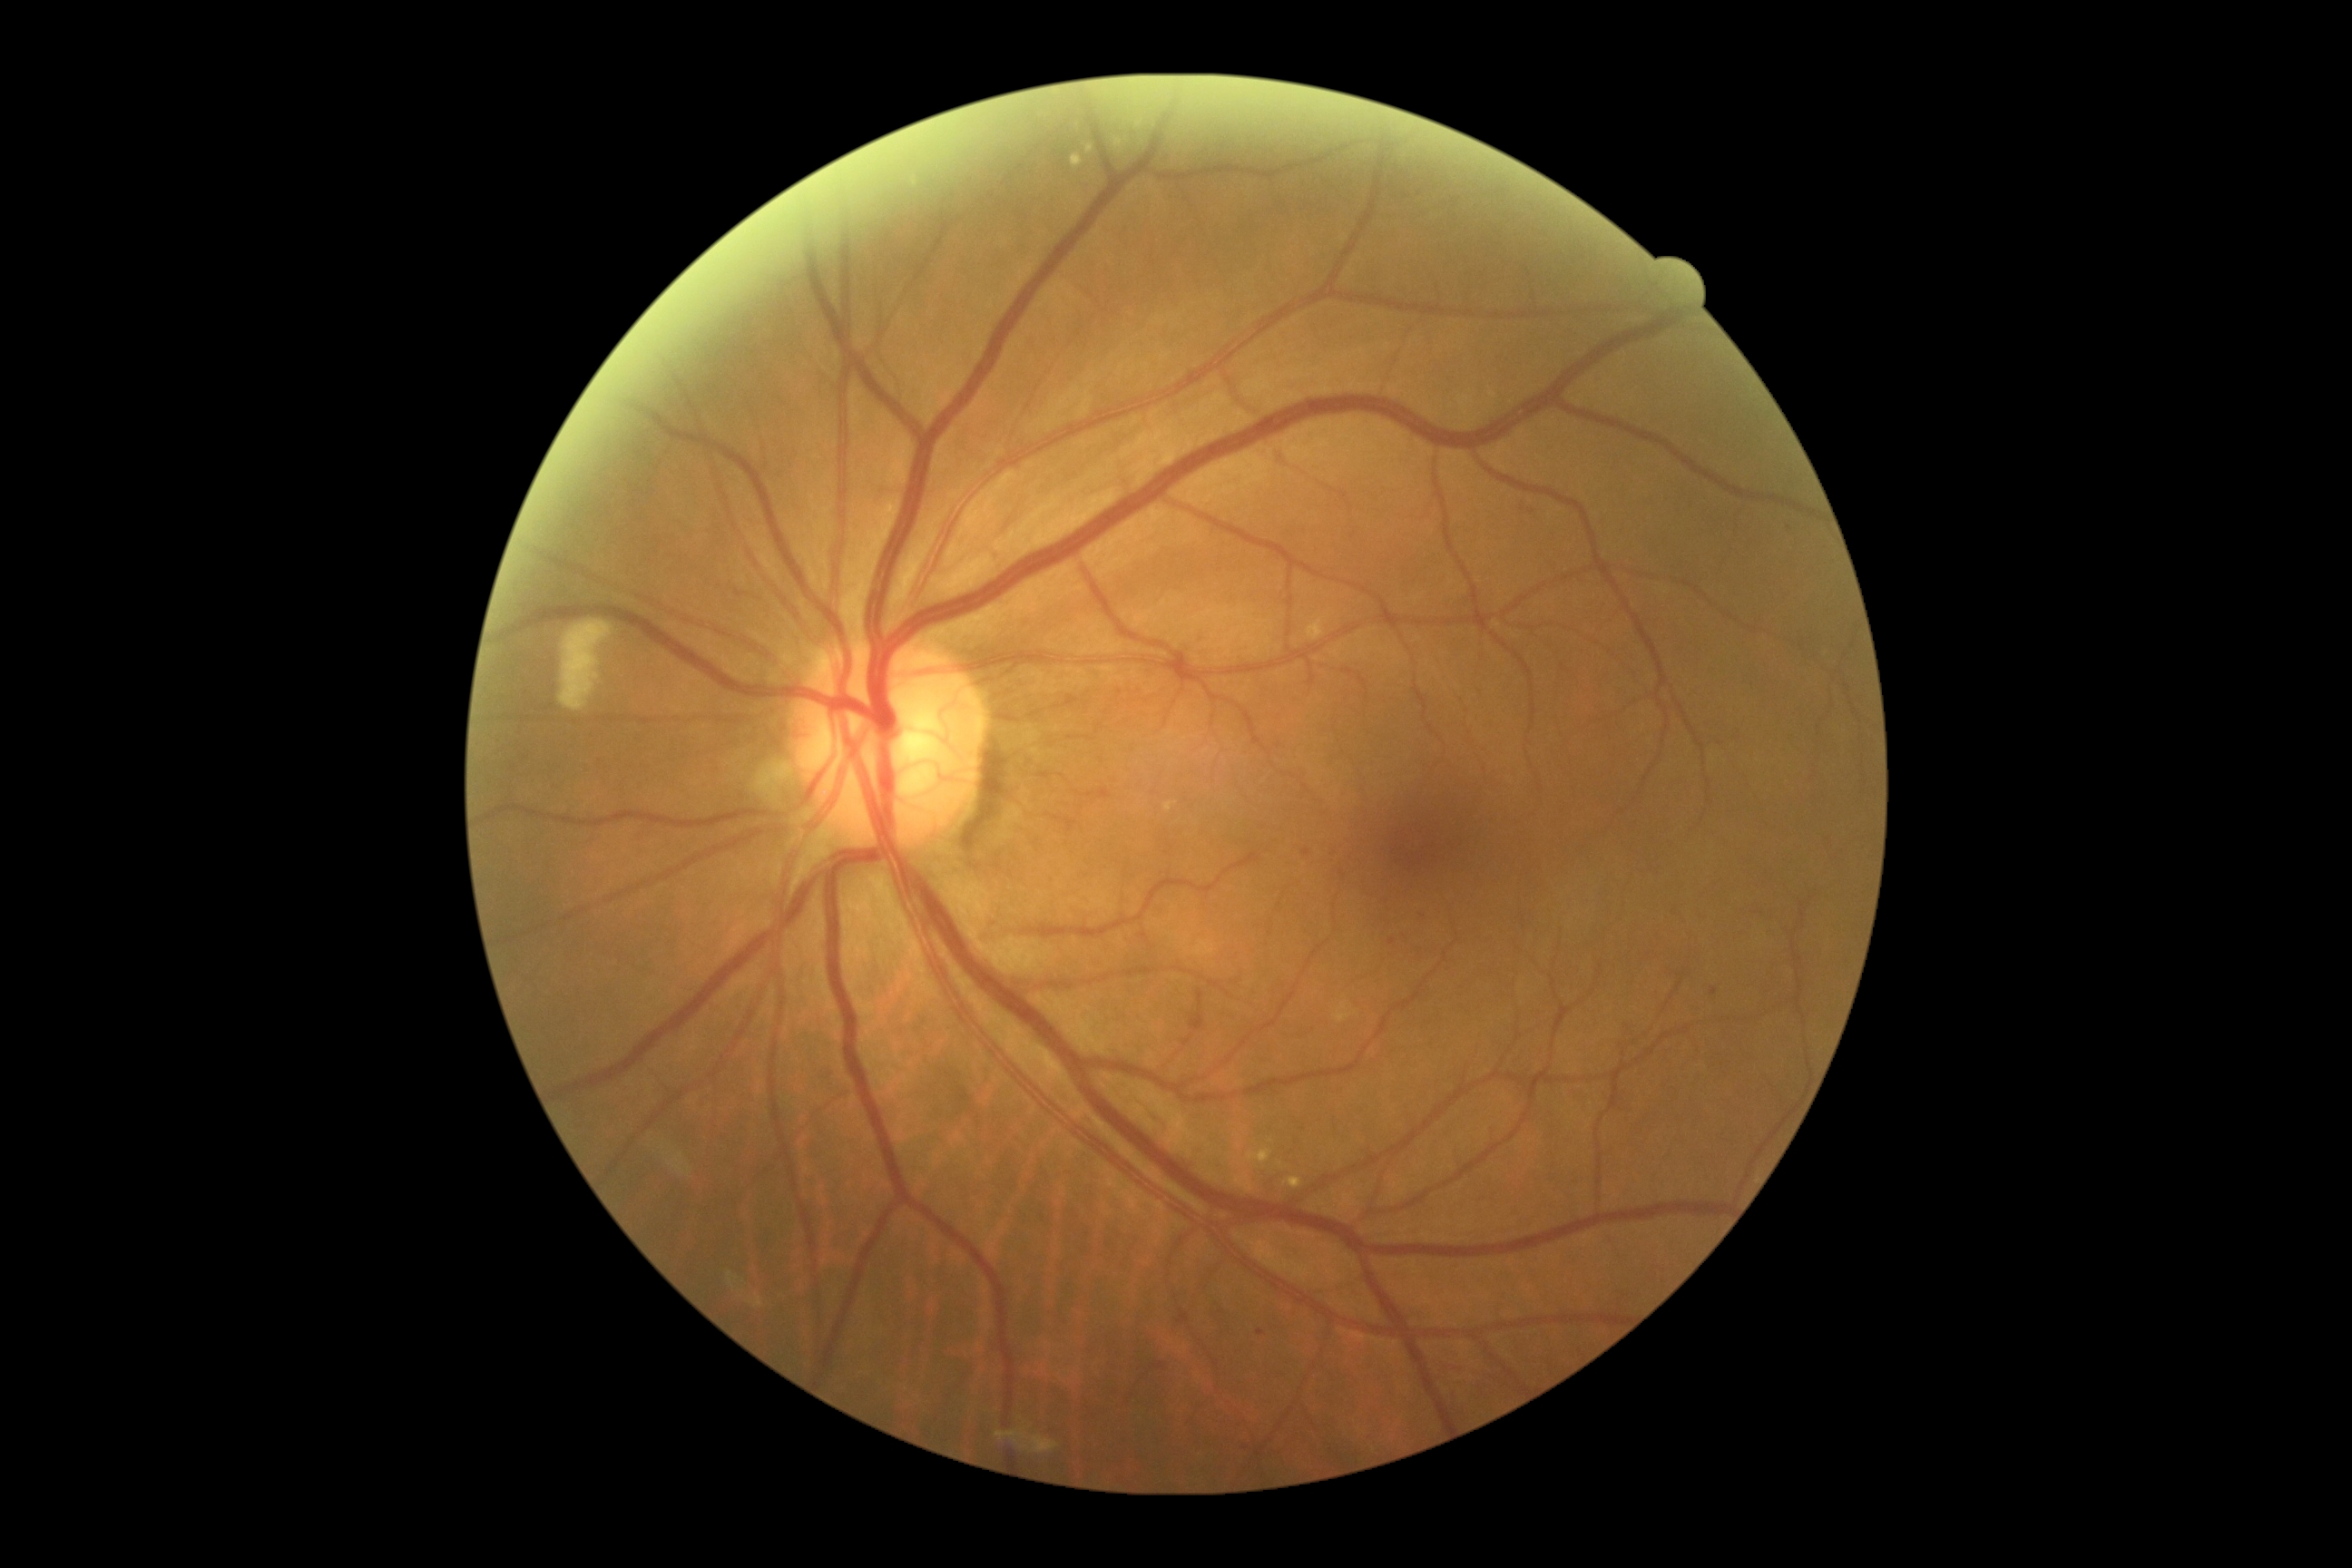

DR class = non-proliferative diabetic retinopathy; diabetic retinopathy (DR) = grade 2 (moderate NPDR).